Phoenix ICON wide-field infant fundus image · captured with the Phoenix ICON (100° field of view) · 1240 x 1240 pixels.
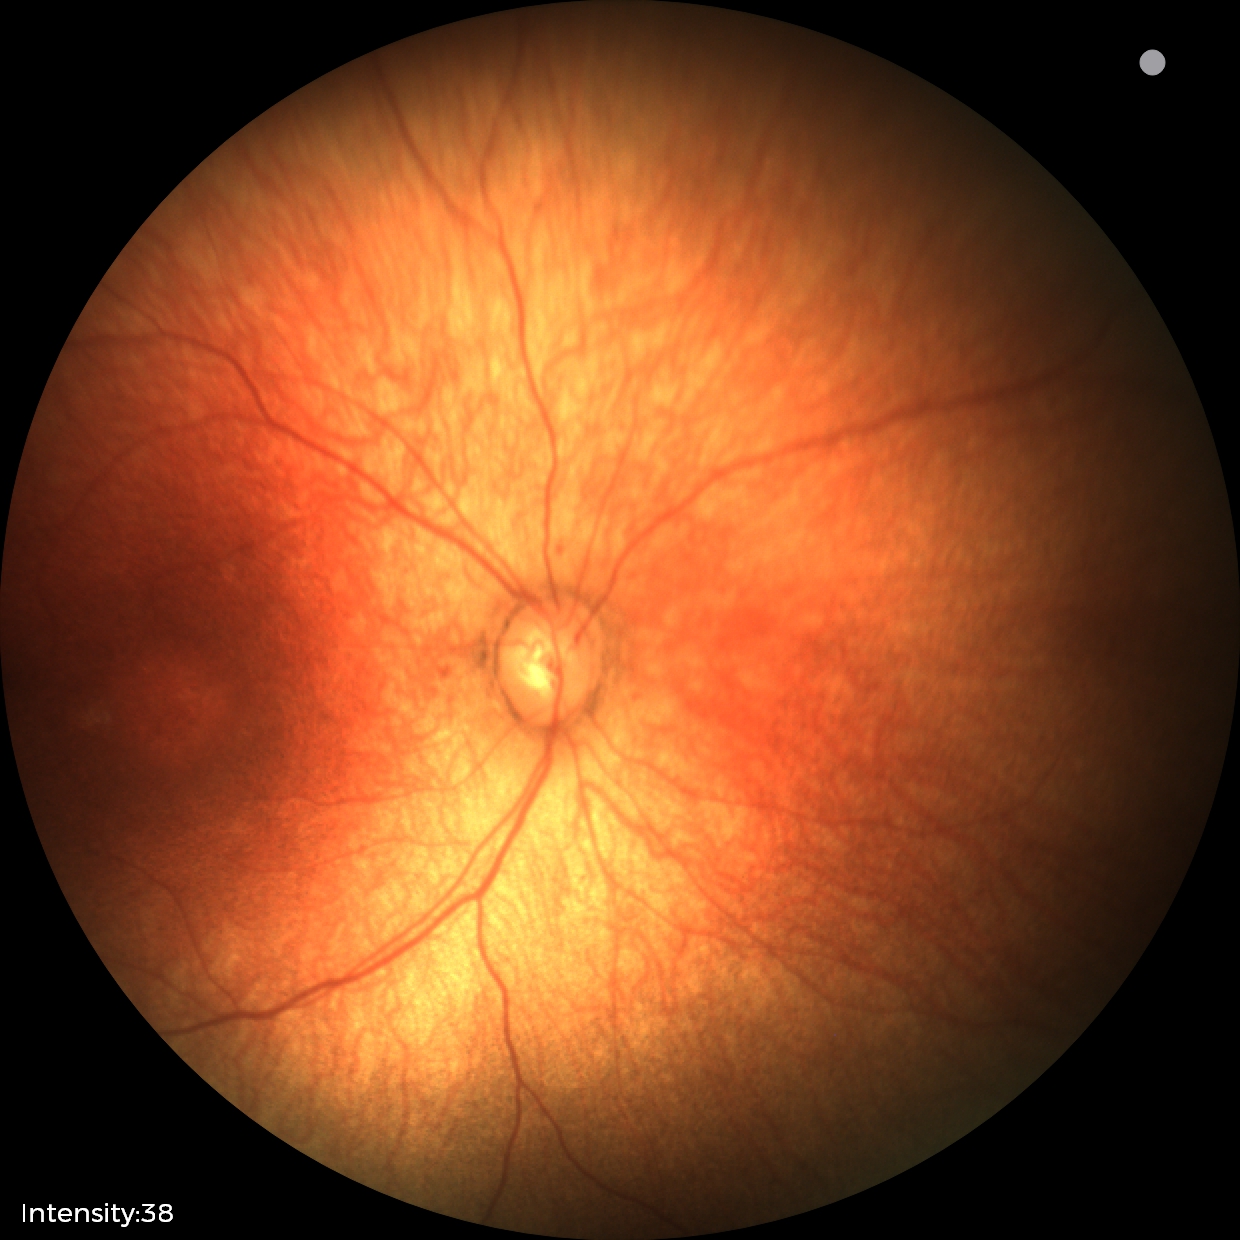
Screening examination with no abnormal retinal findings.